1659x2212.
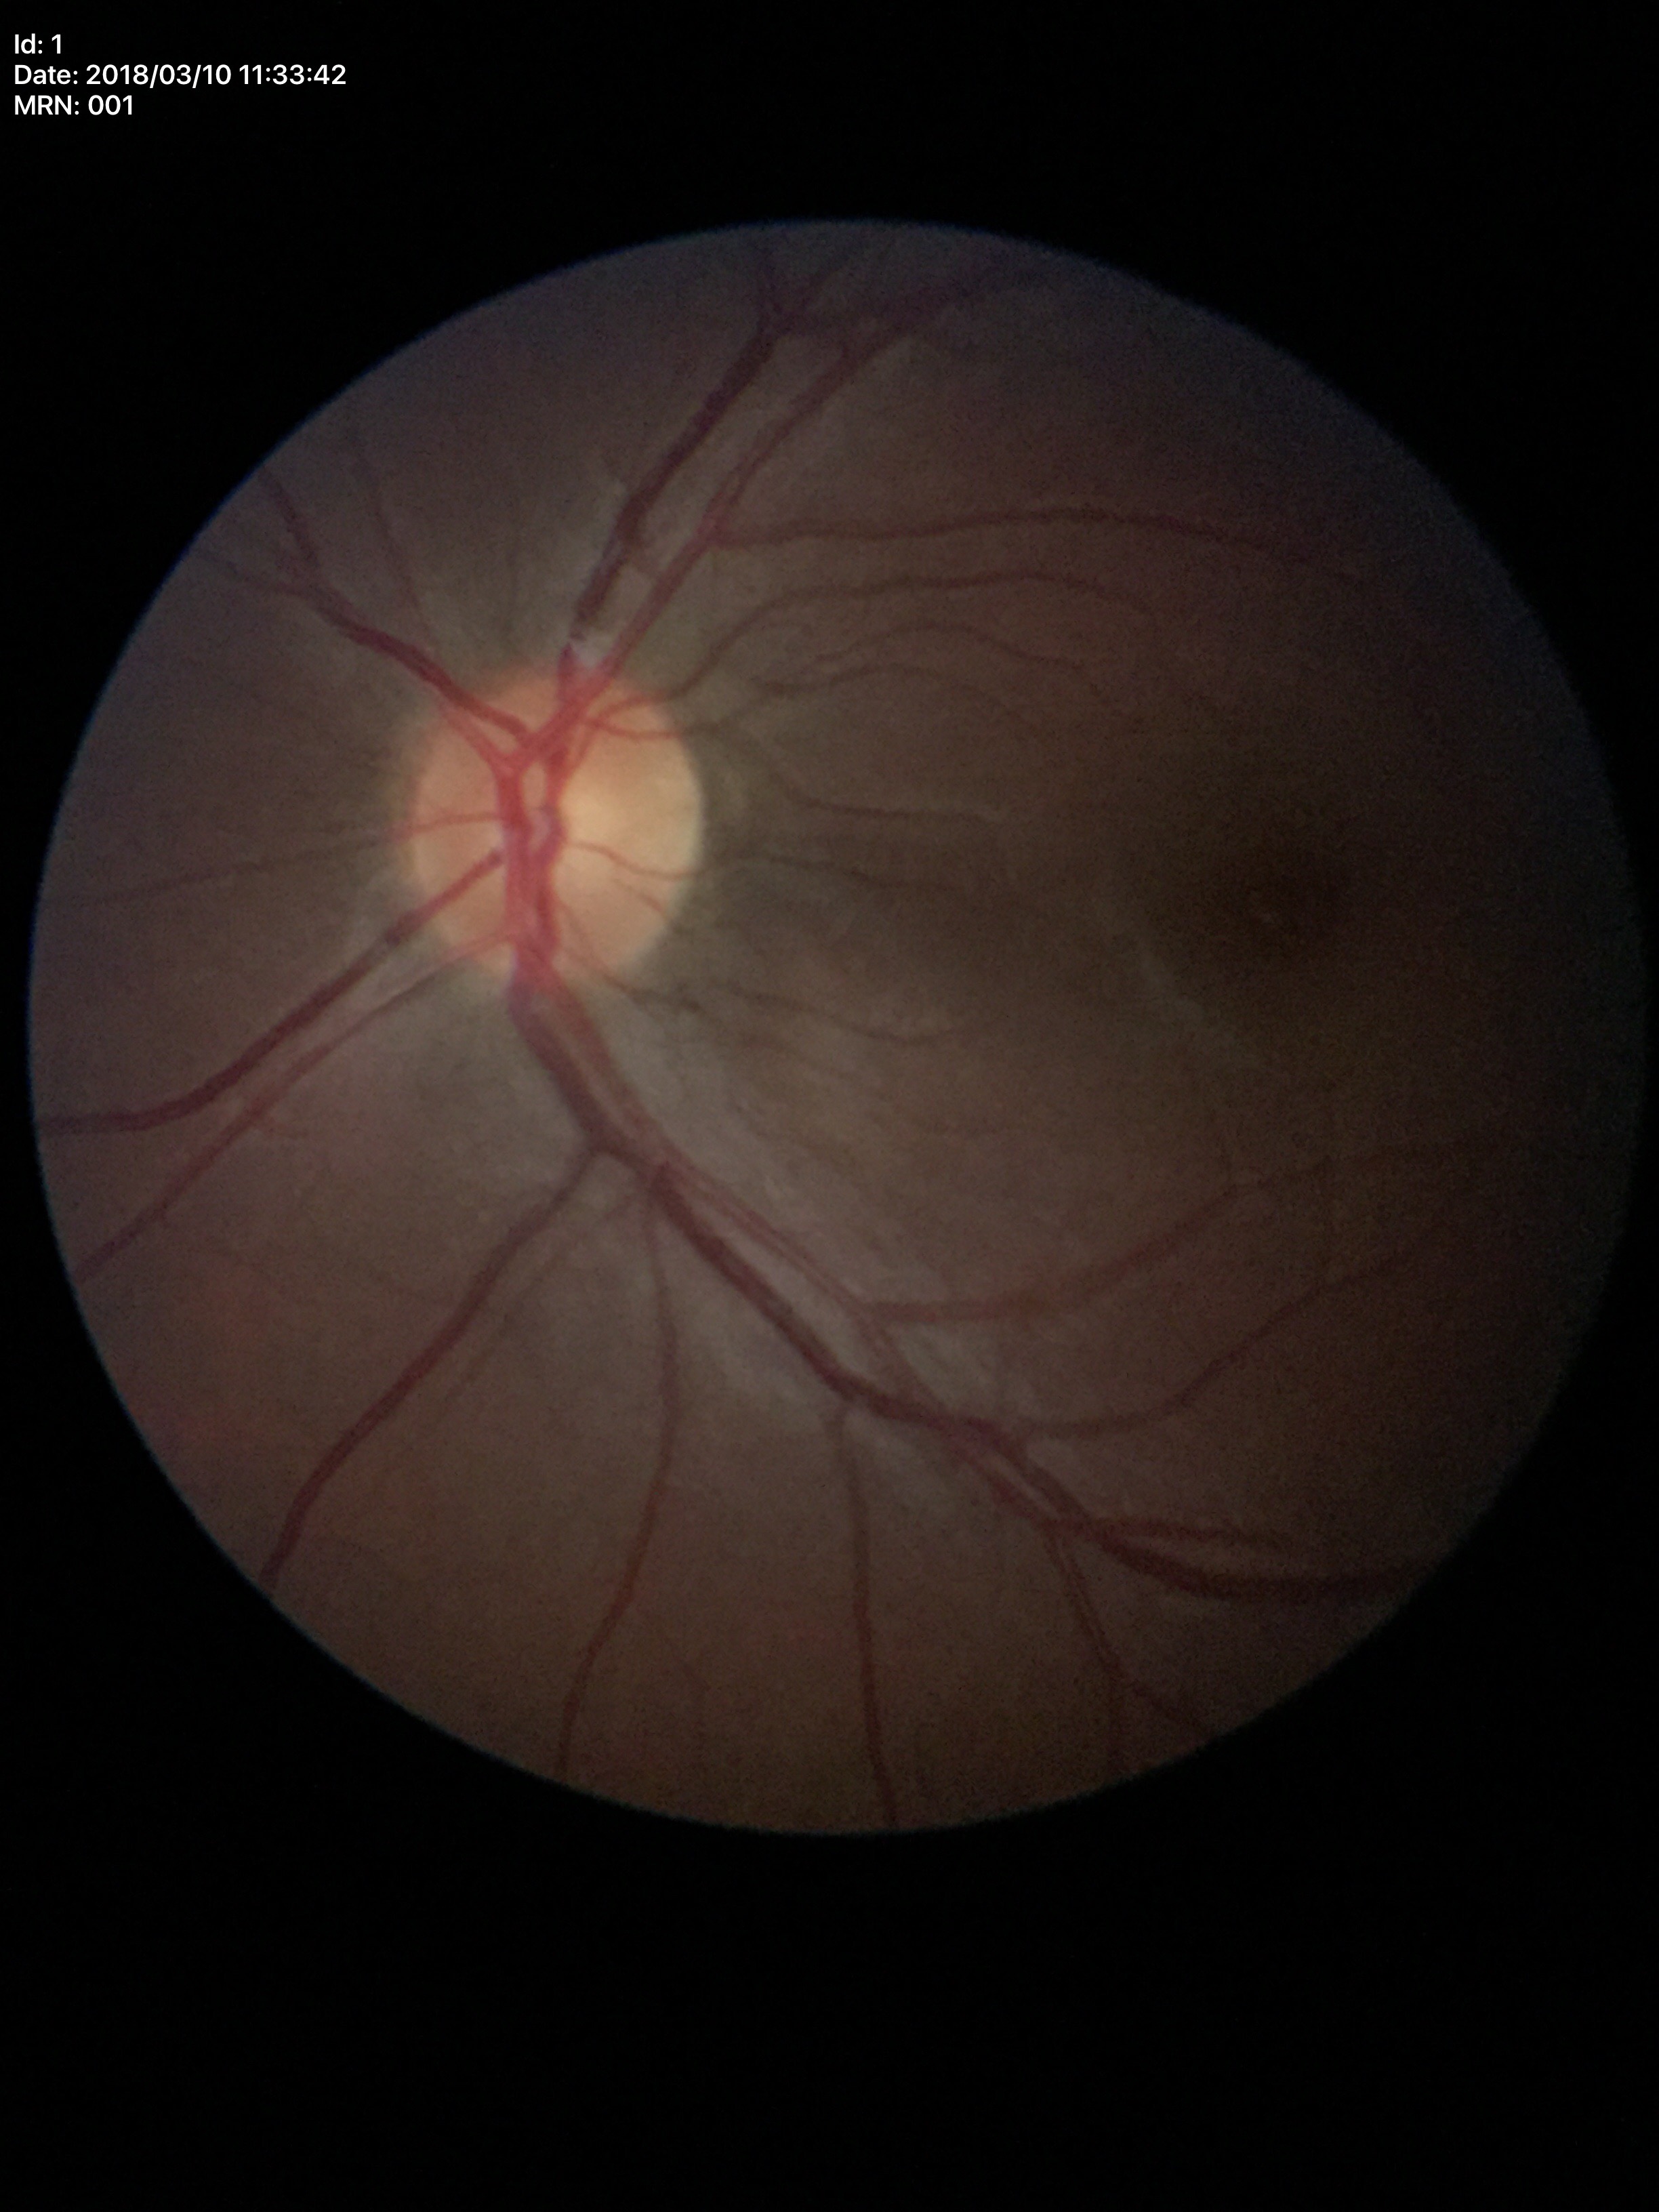
HCDR of 0.42. VCDR of 0.50. No glaucomatous optic neuropathy.